Image size 240x240
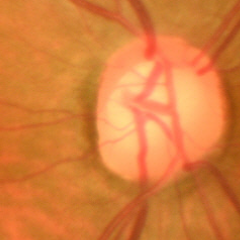
Glaucoma assessment: no glaucomatous changes.